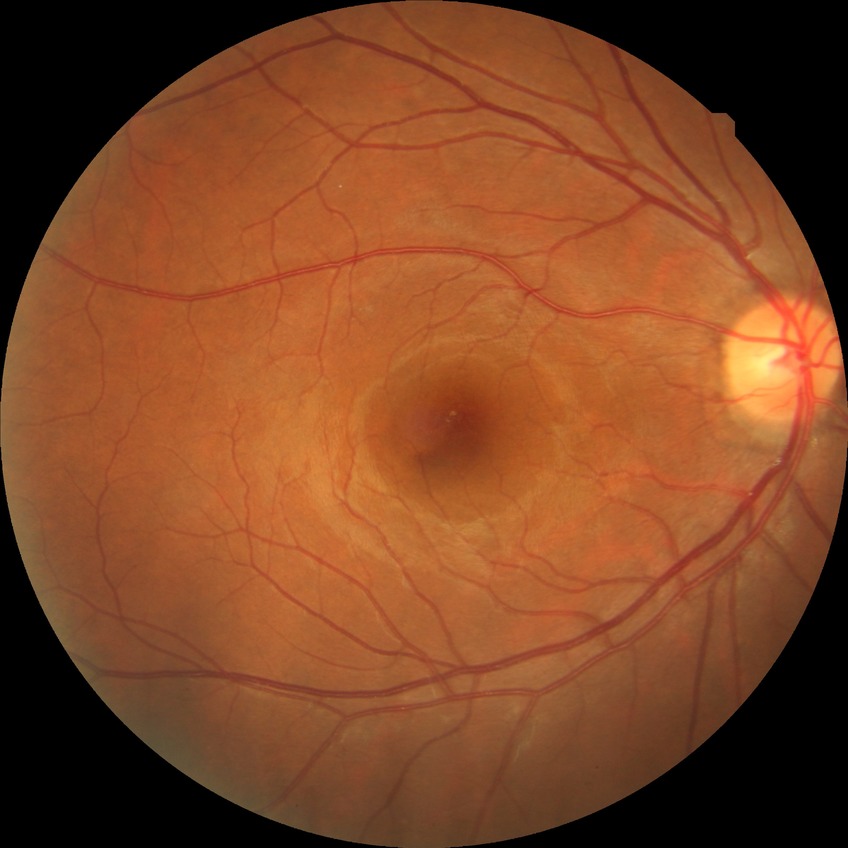 Modified Davis classification is no diabetic retinopathy.